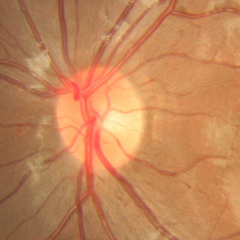 Glaucoma stage = no glaucomatous changes.